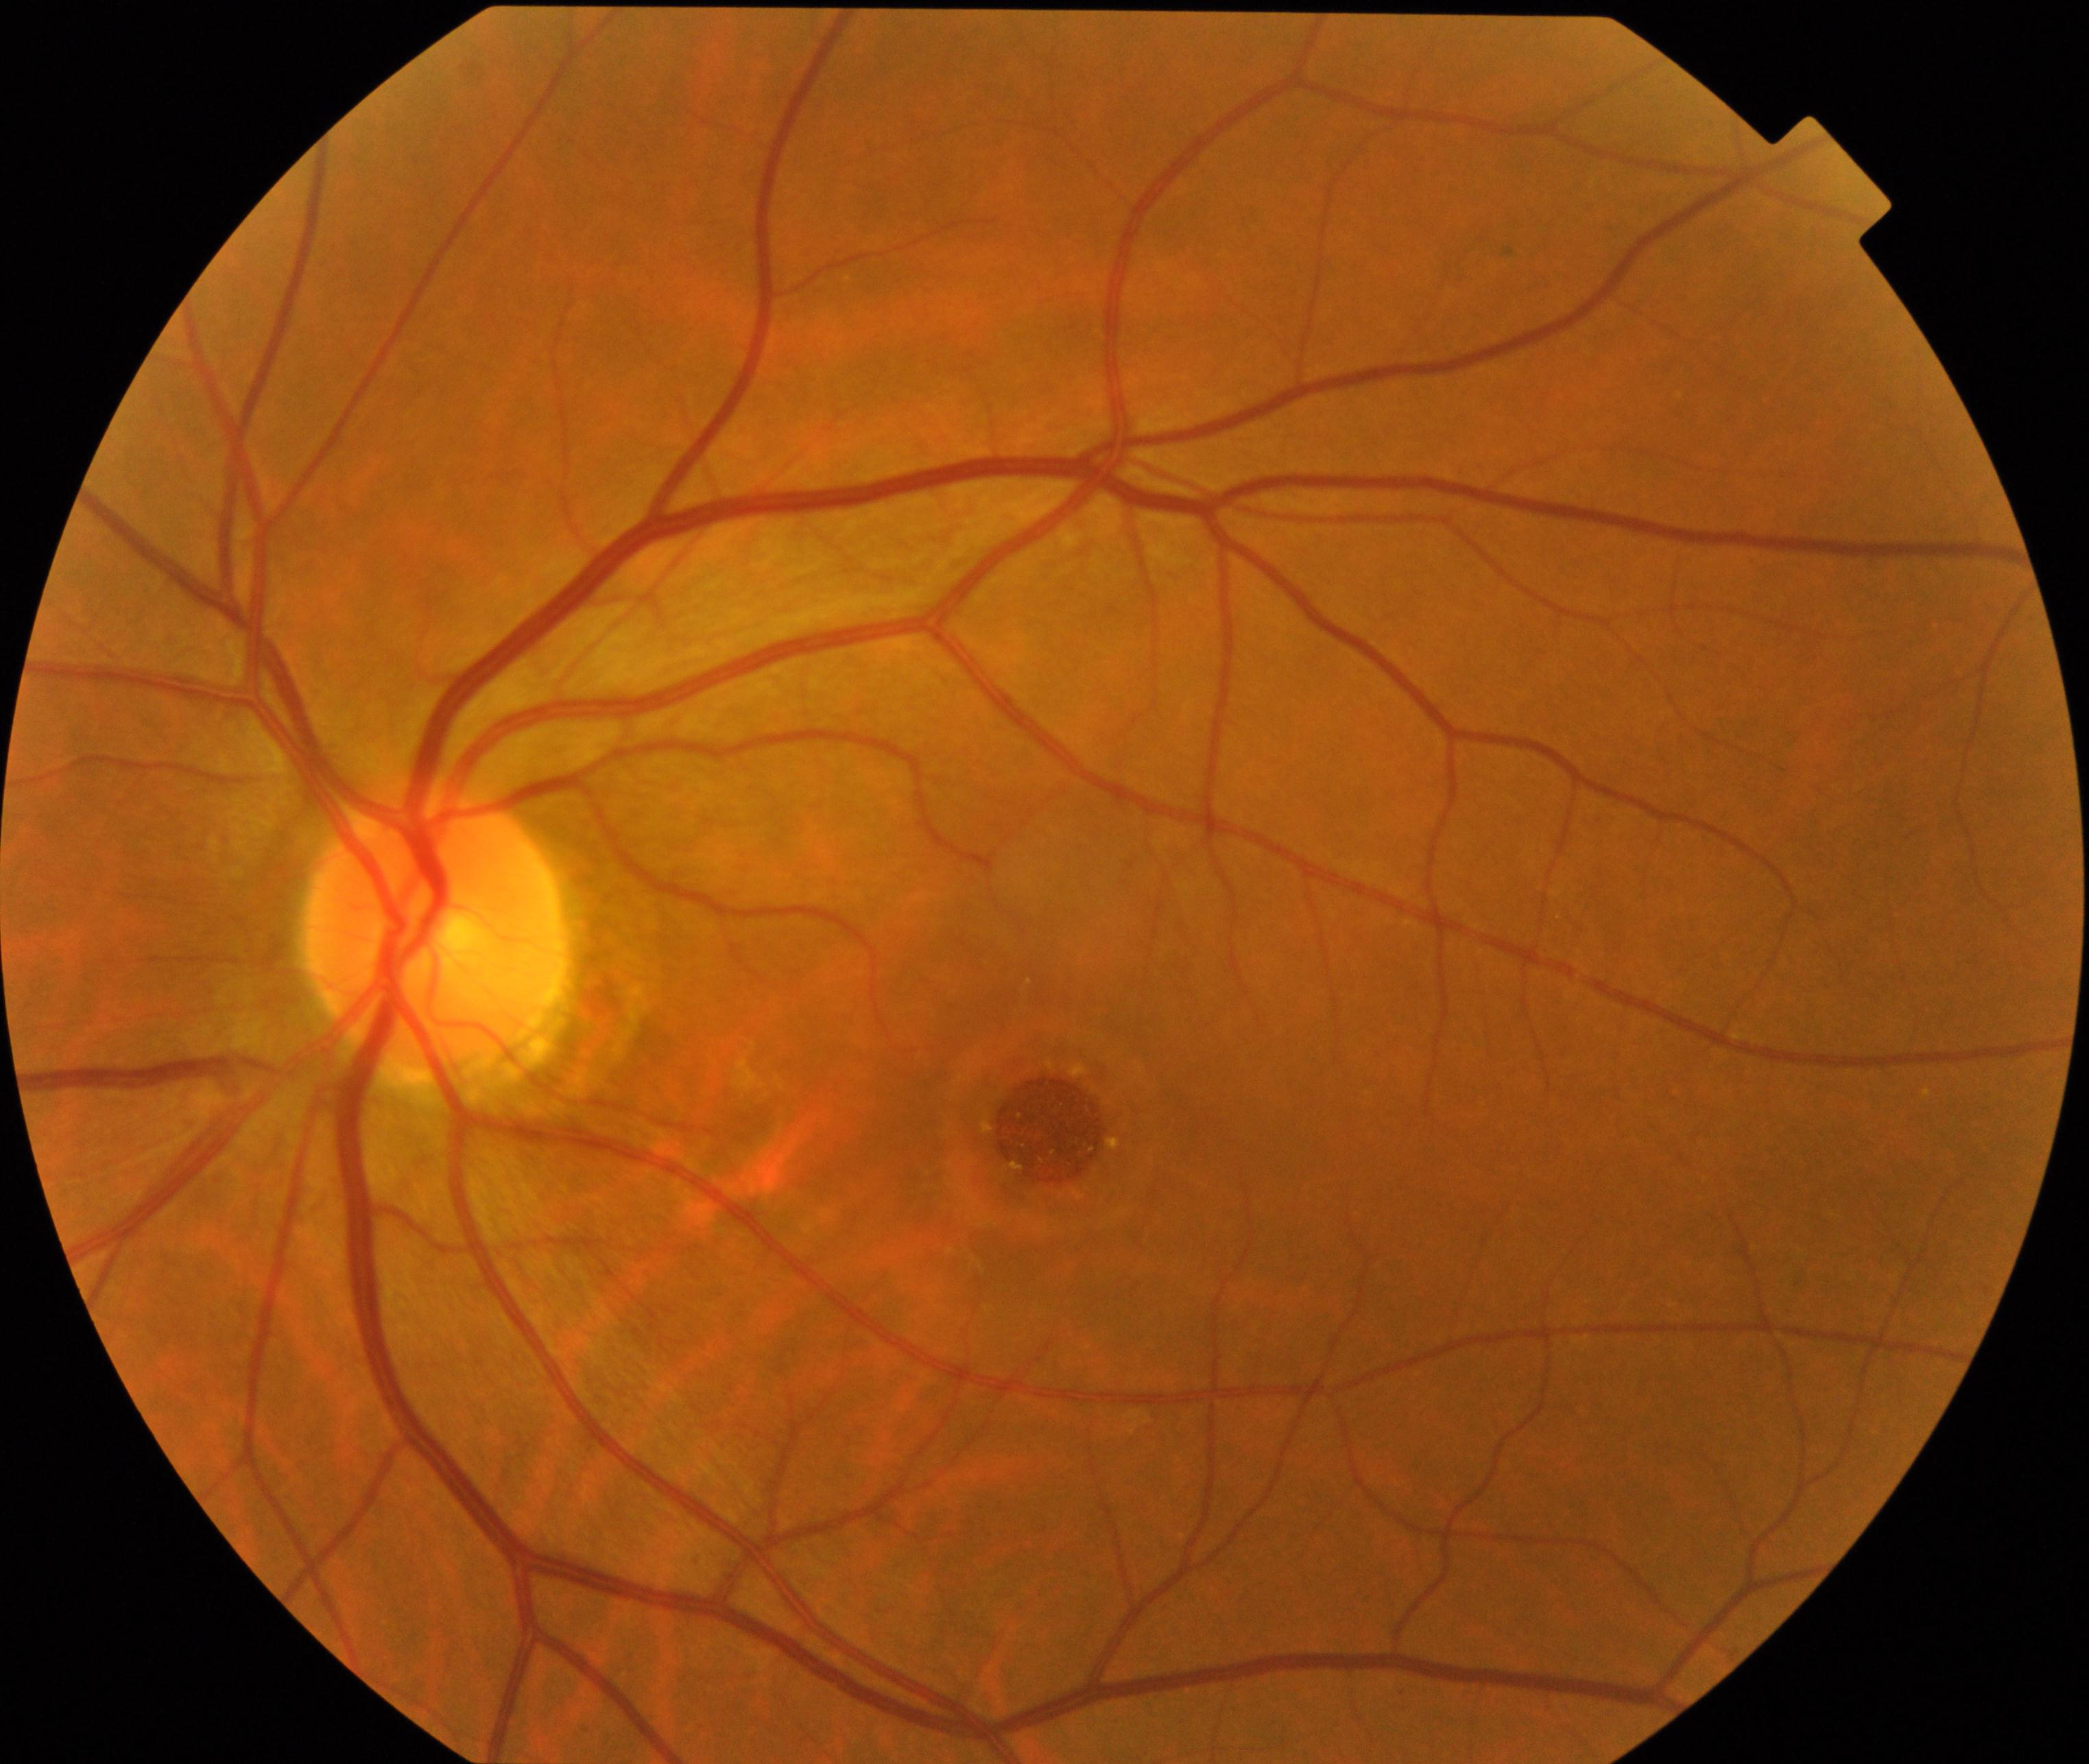

Retinal fundus photograph demonstrating macular hole. Defined by central foveal defect, round or oval, sometimes with multiple yellow deposits within the crater or a surrounding cuff of subretinal fluid.